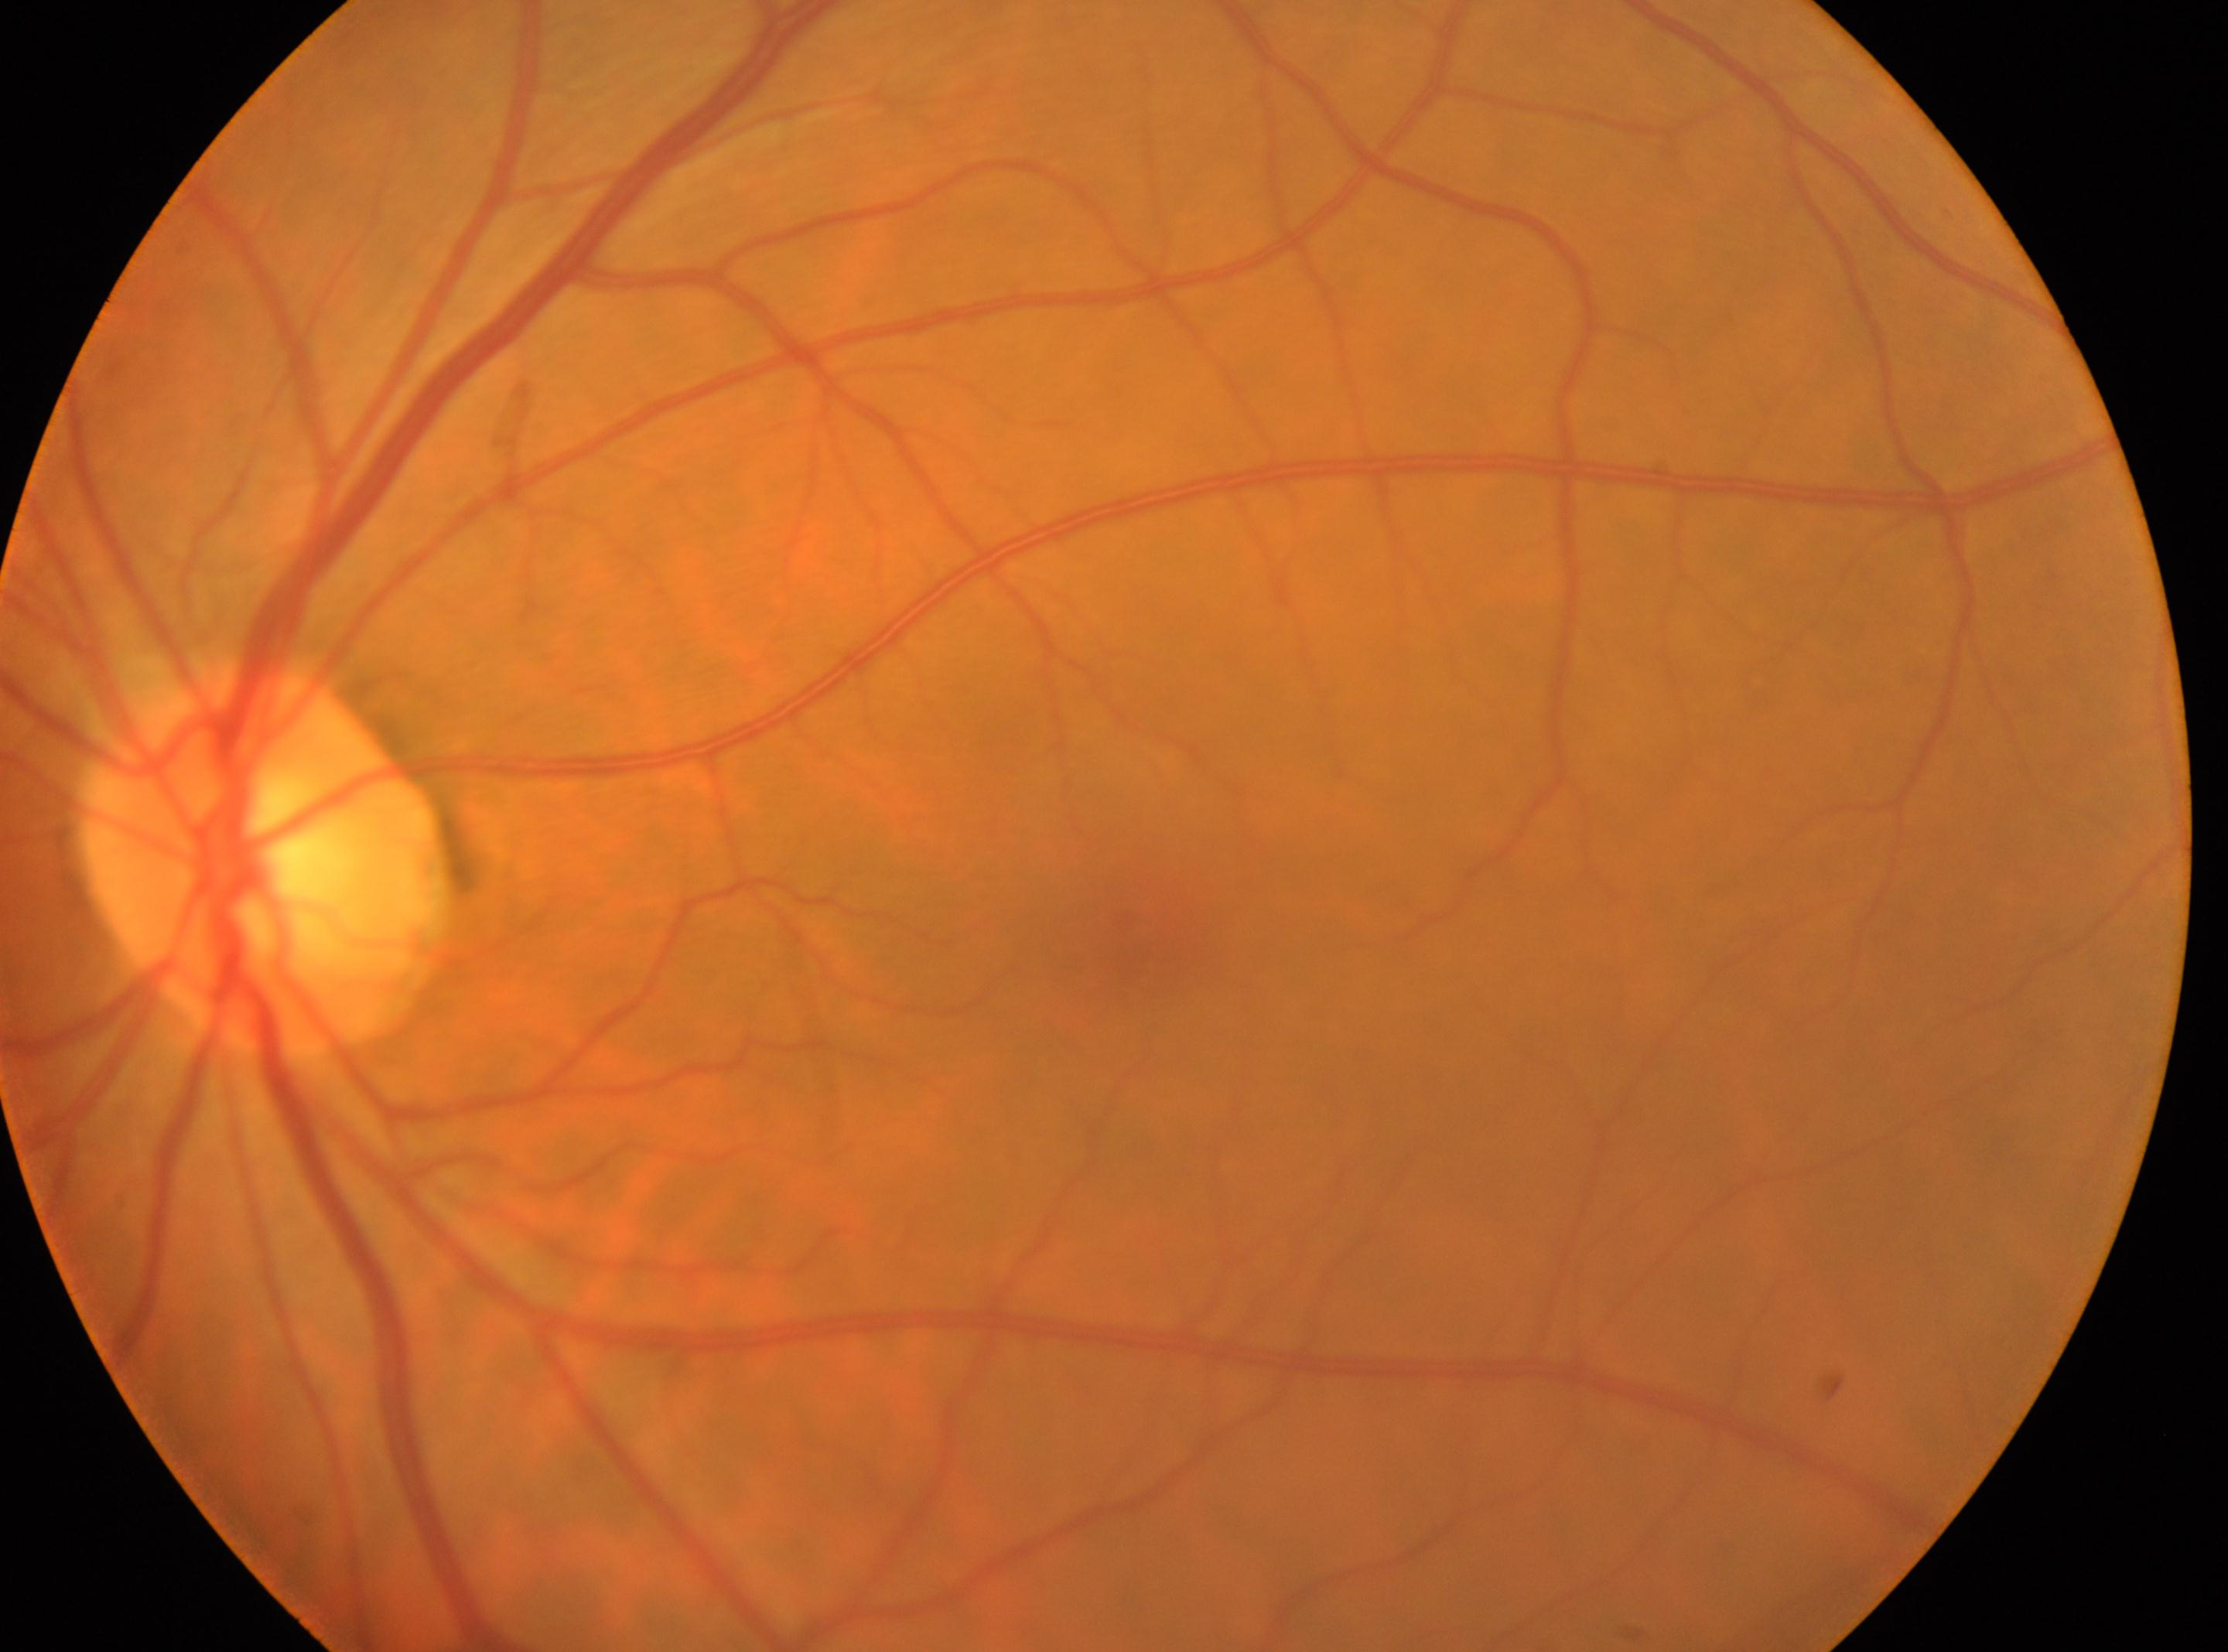
diabetic retinopathy (DR): grade 0
fovea centralis: (1134,920)
optic disk: (263,855)
laterality: the left eye